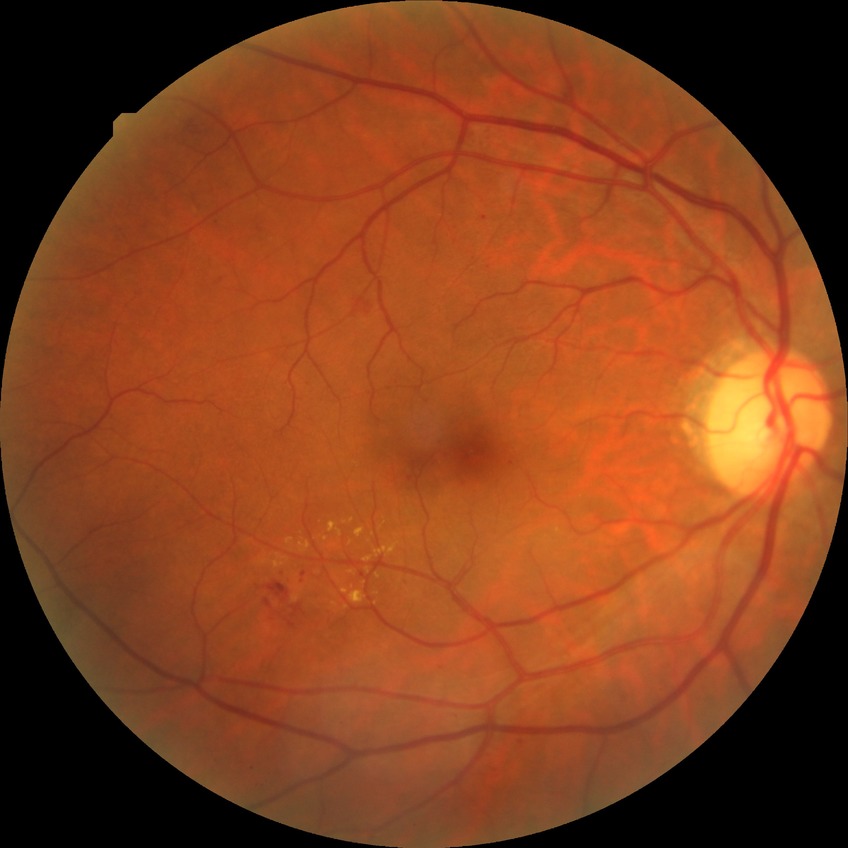

Diabetic retinopathy (DR) is simple diabetic retinopathy (SDR). The retinopathy is classified as non-proliferative diabetic retinopathy.